Color fundus photograph.
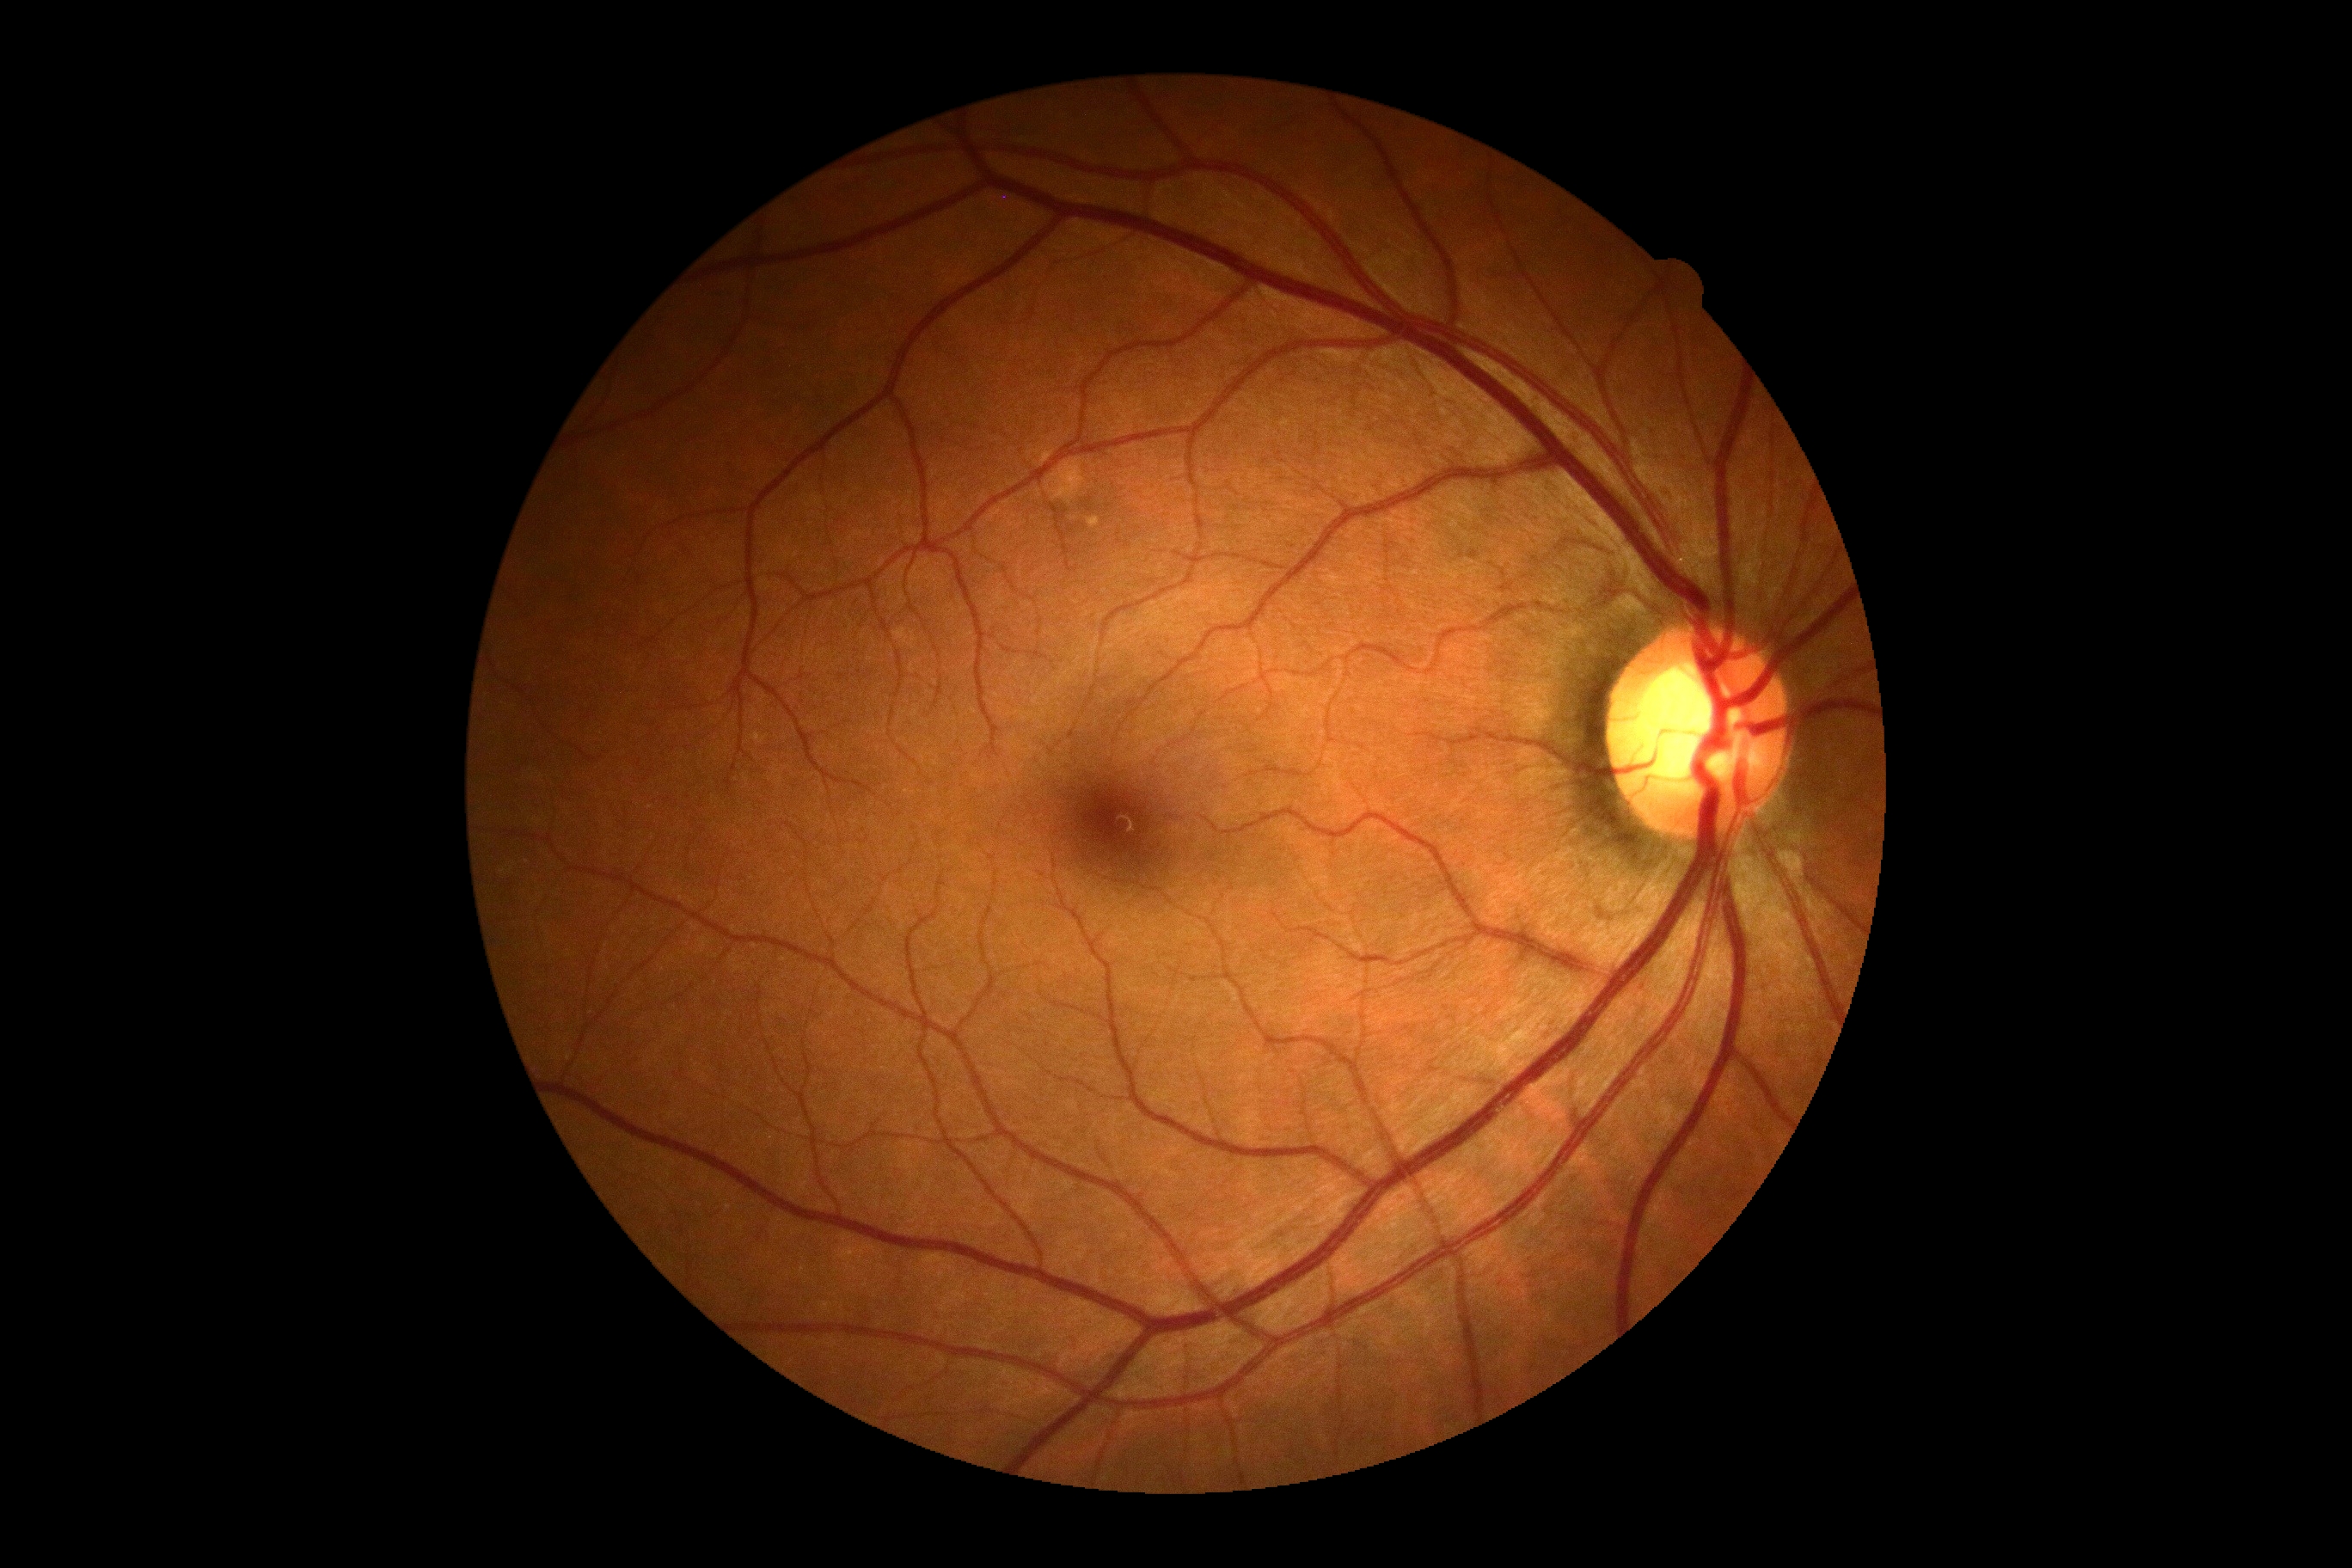
DR grade is no apparent diabetic retinopathy (0).